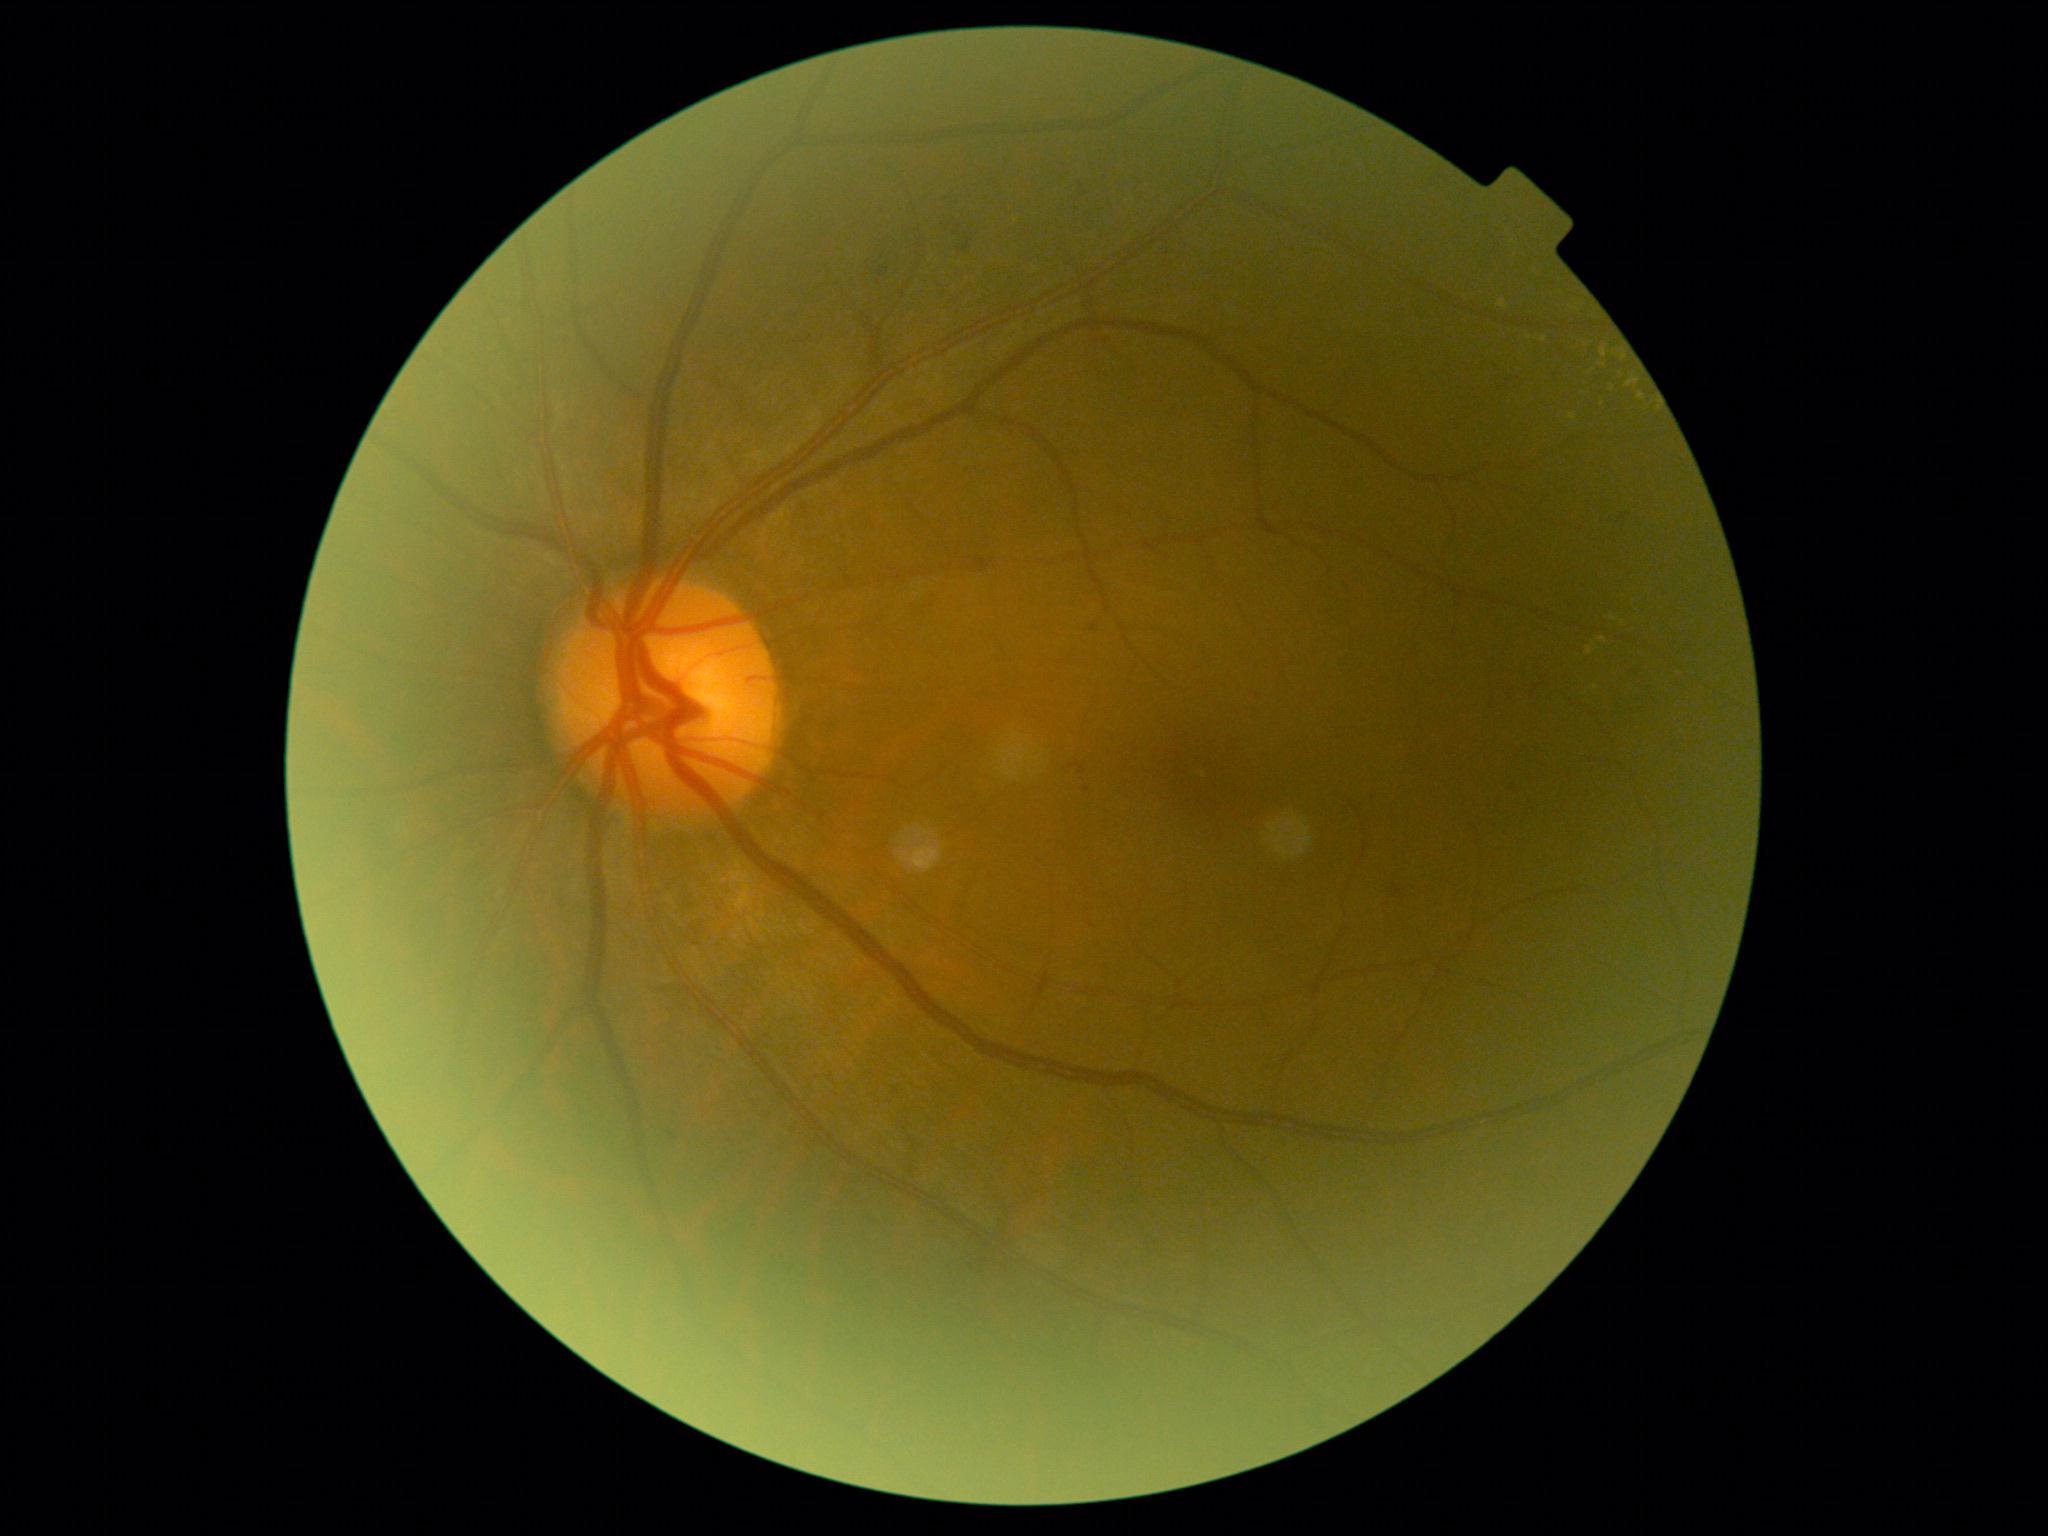
DR=grade 2 (moderate NPDR).